Acquired with a Remidio Fundus on Phone — 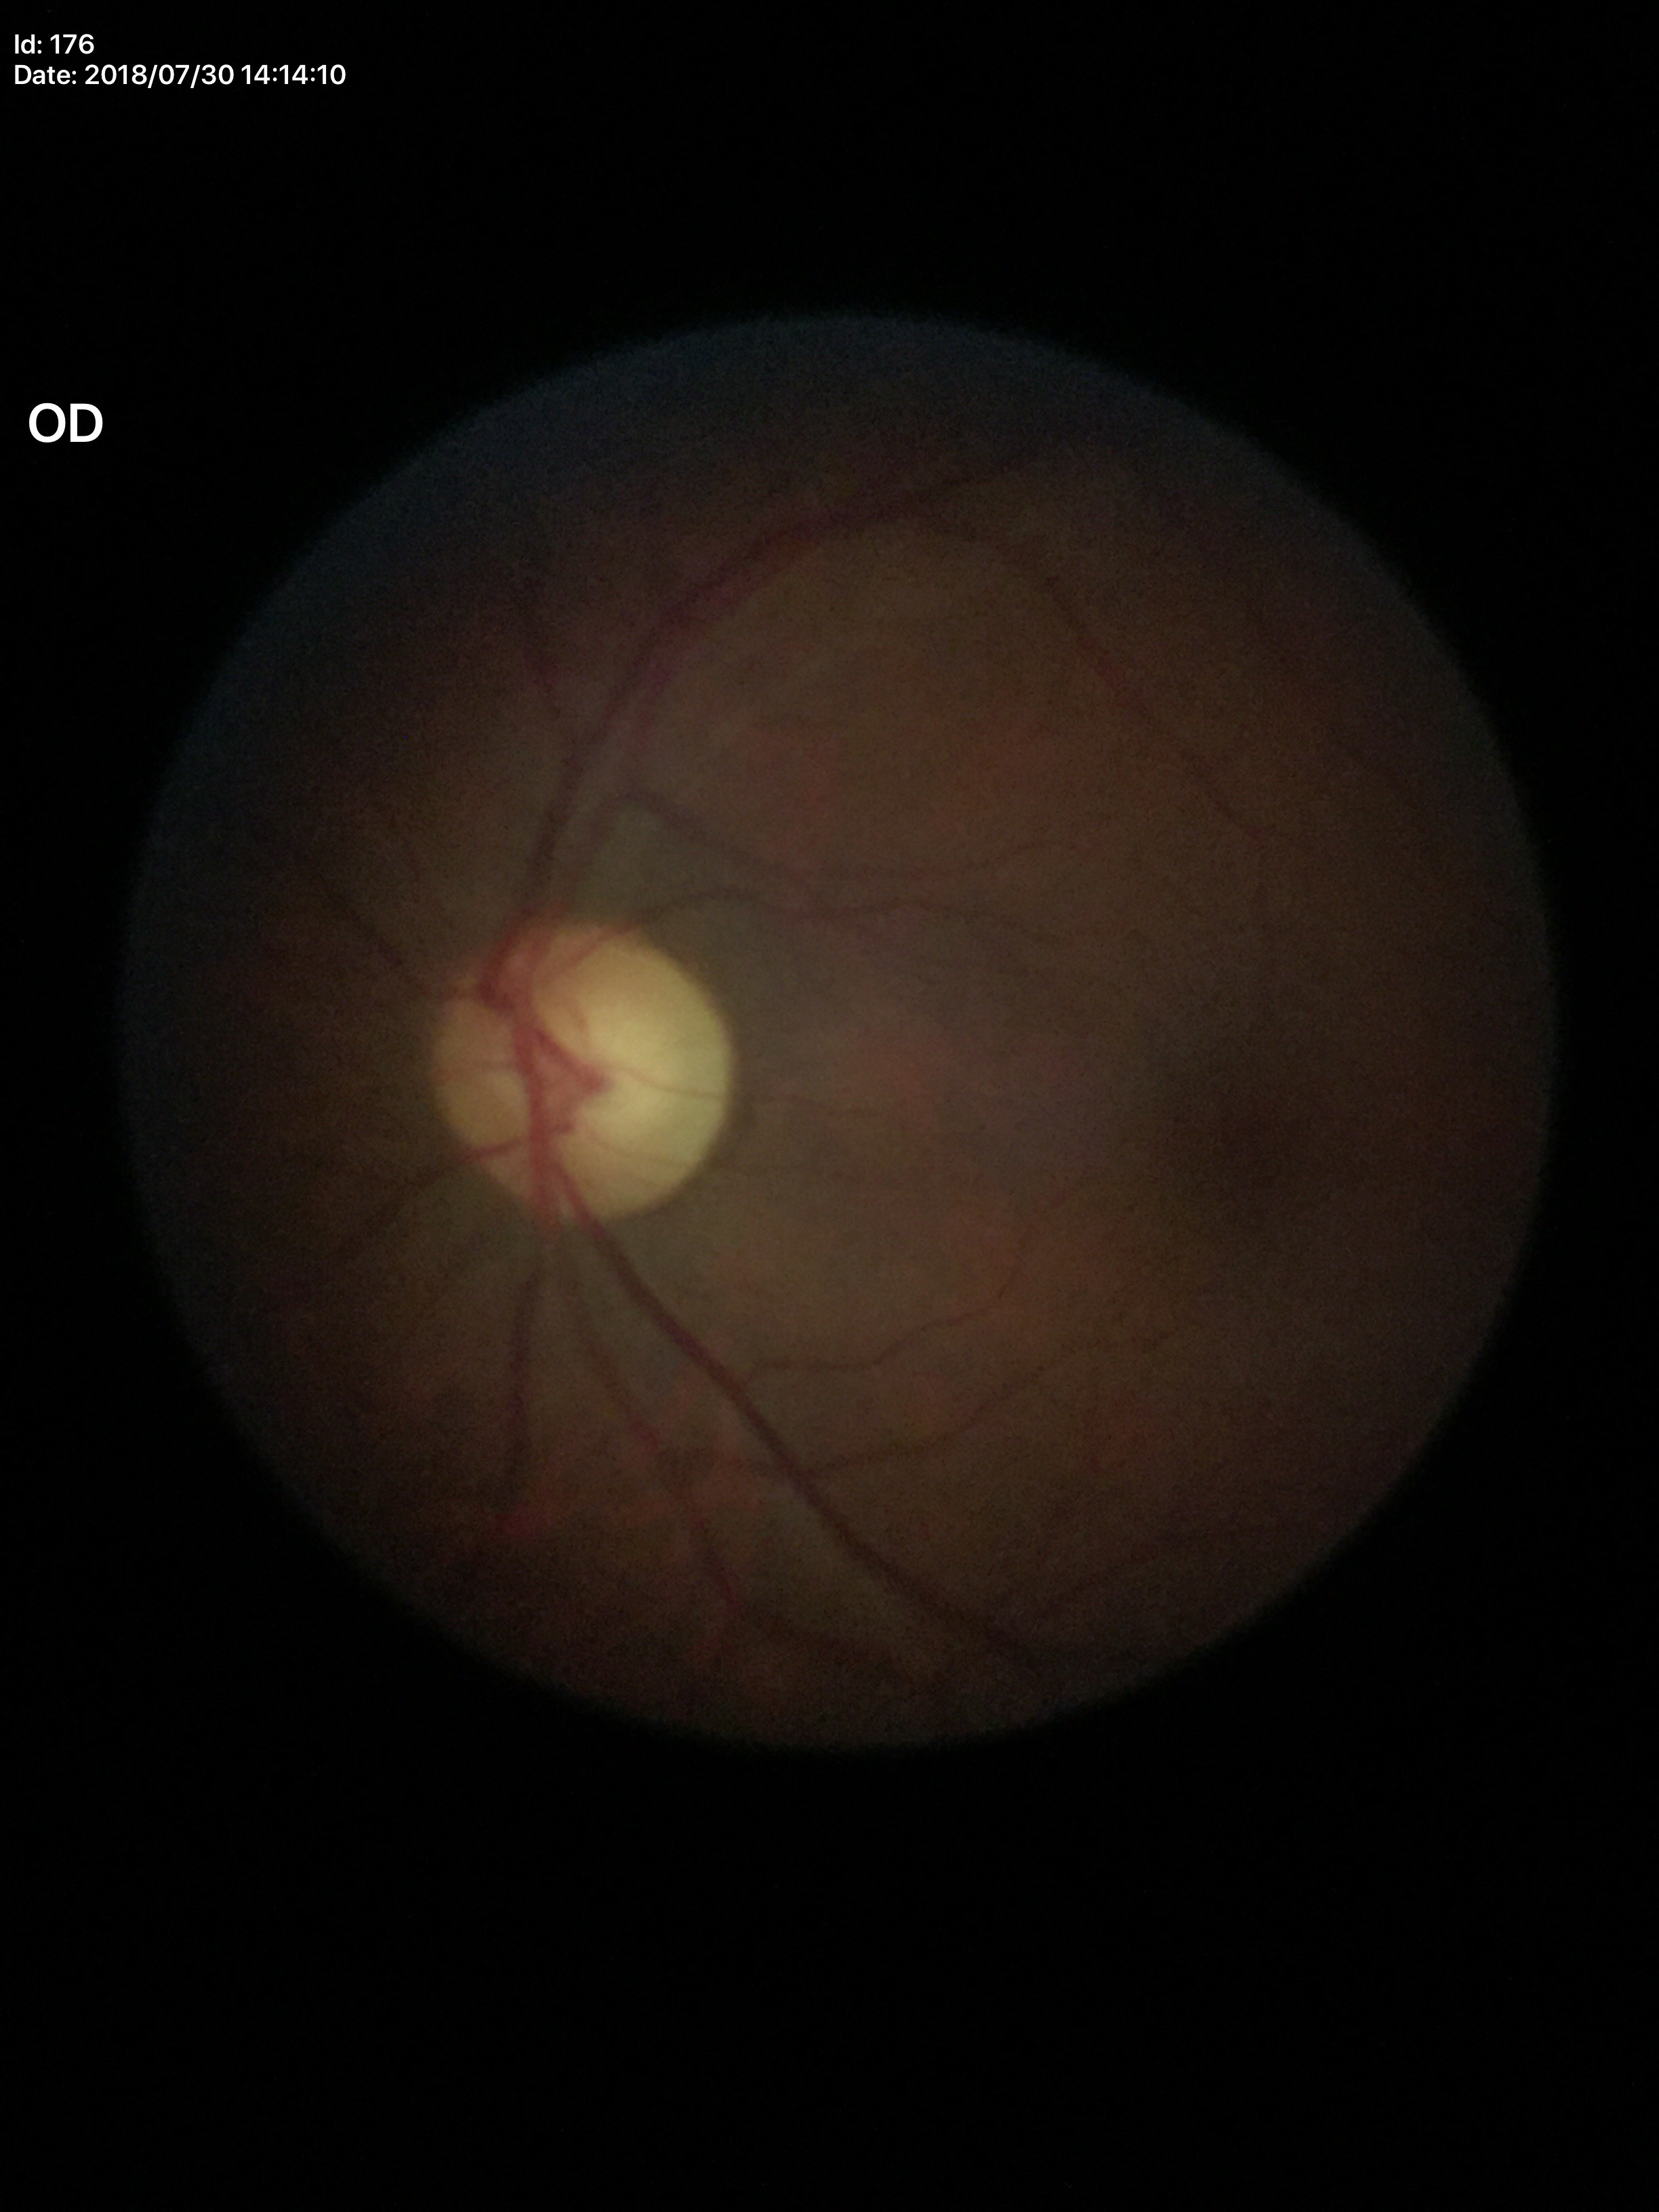 Glaucoma decision: negative (one of five ophthalmologists flagged glaucoma suspect).
VCDR of 0.57.